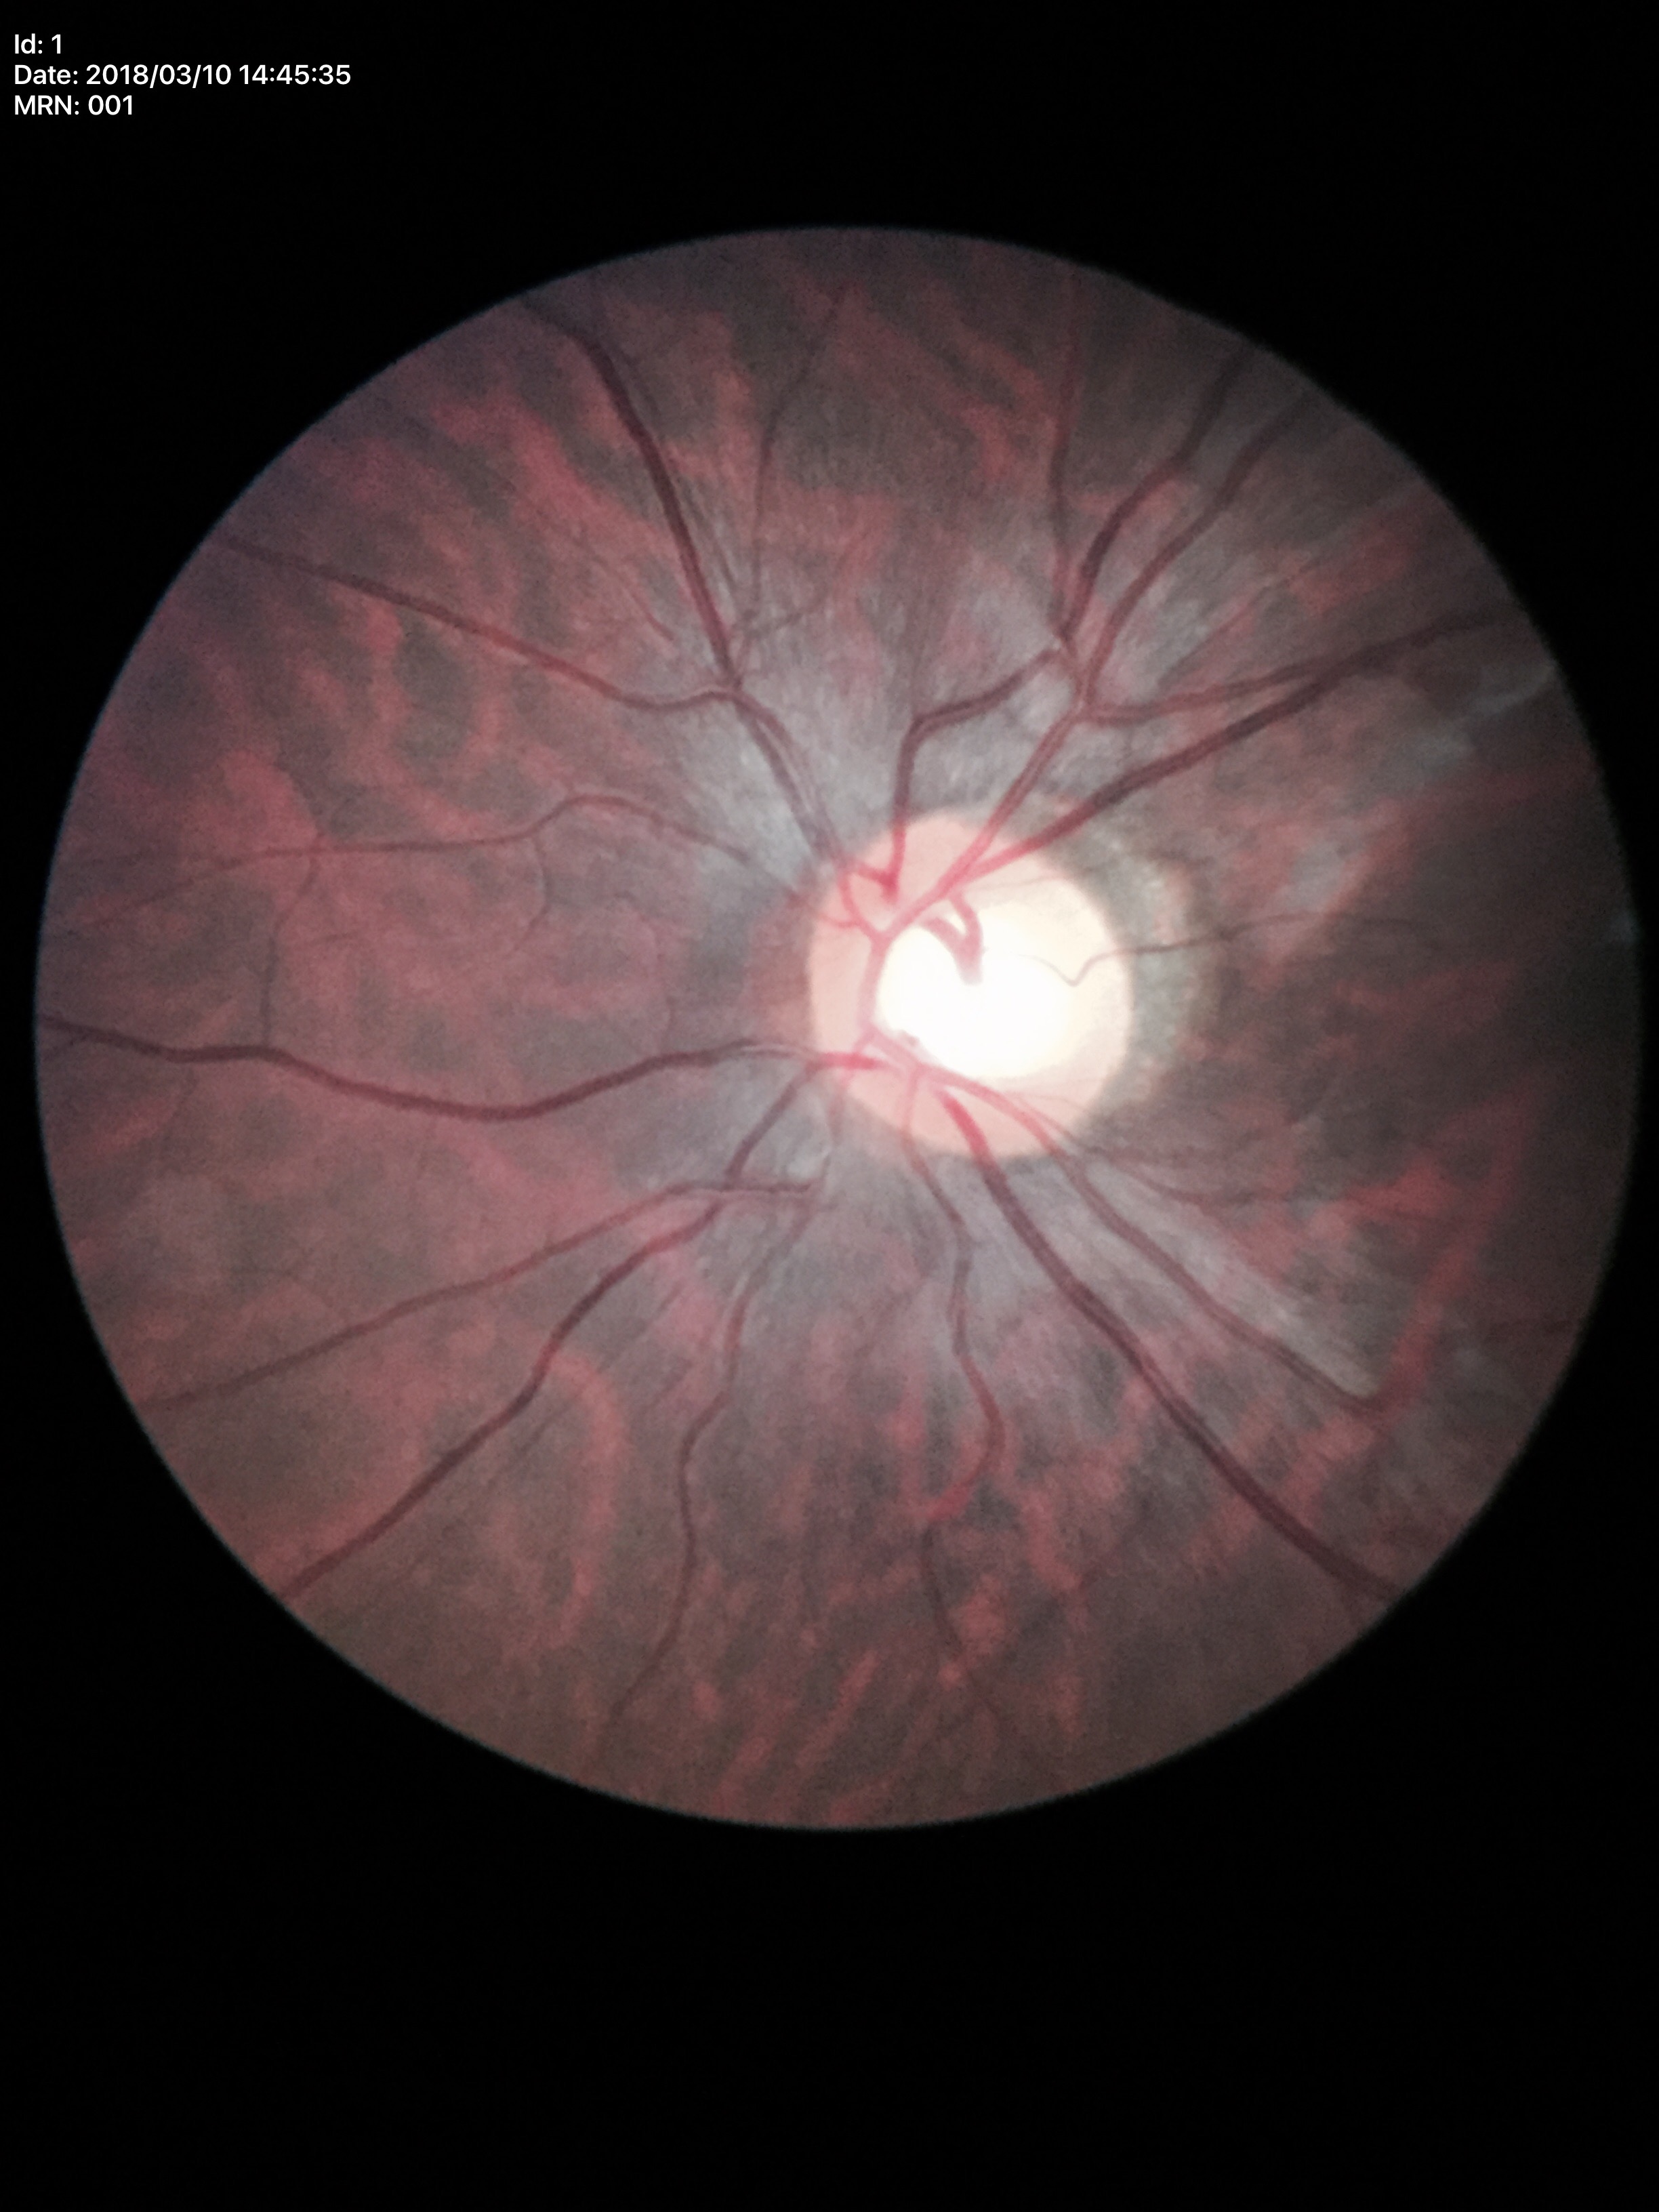
Glaucoma-suspect optic disc appearance (4 of 5 graders flagged glaucoma suspect). Vertical CDR (VCDR): 0.62.